45° FOV
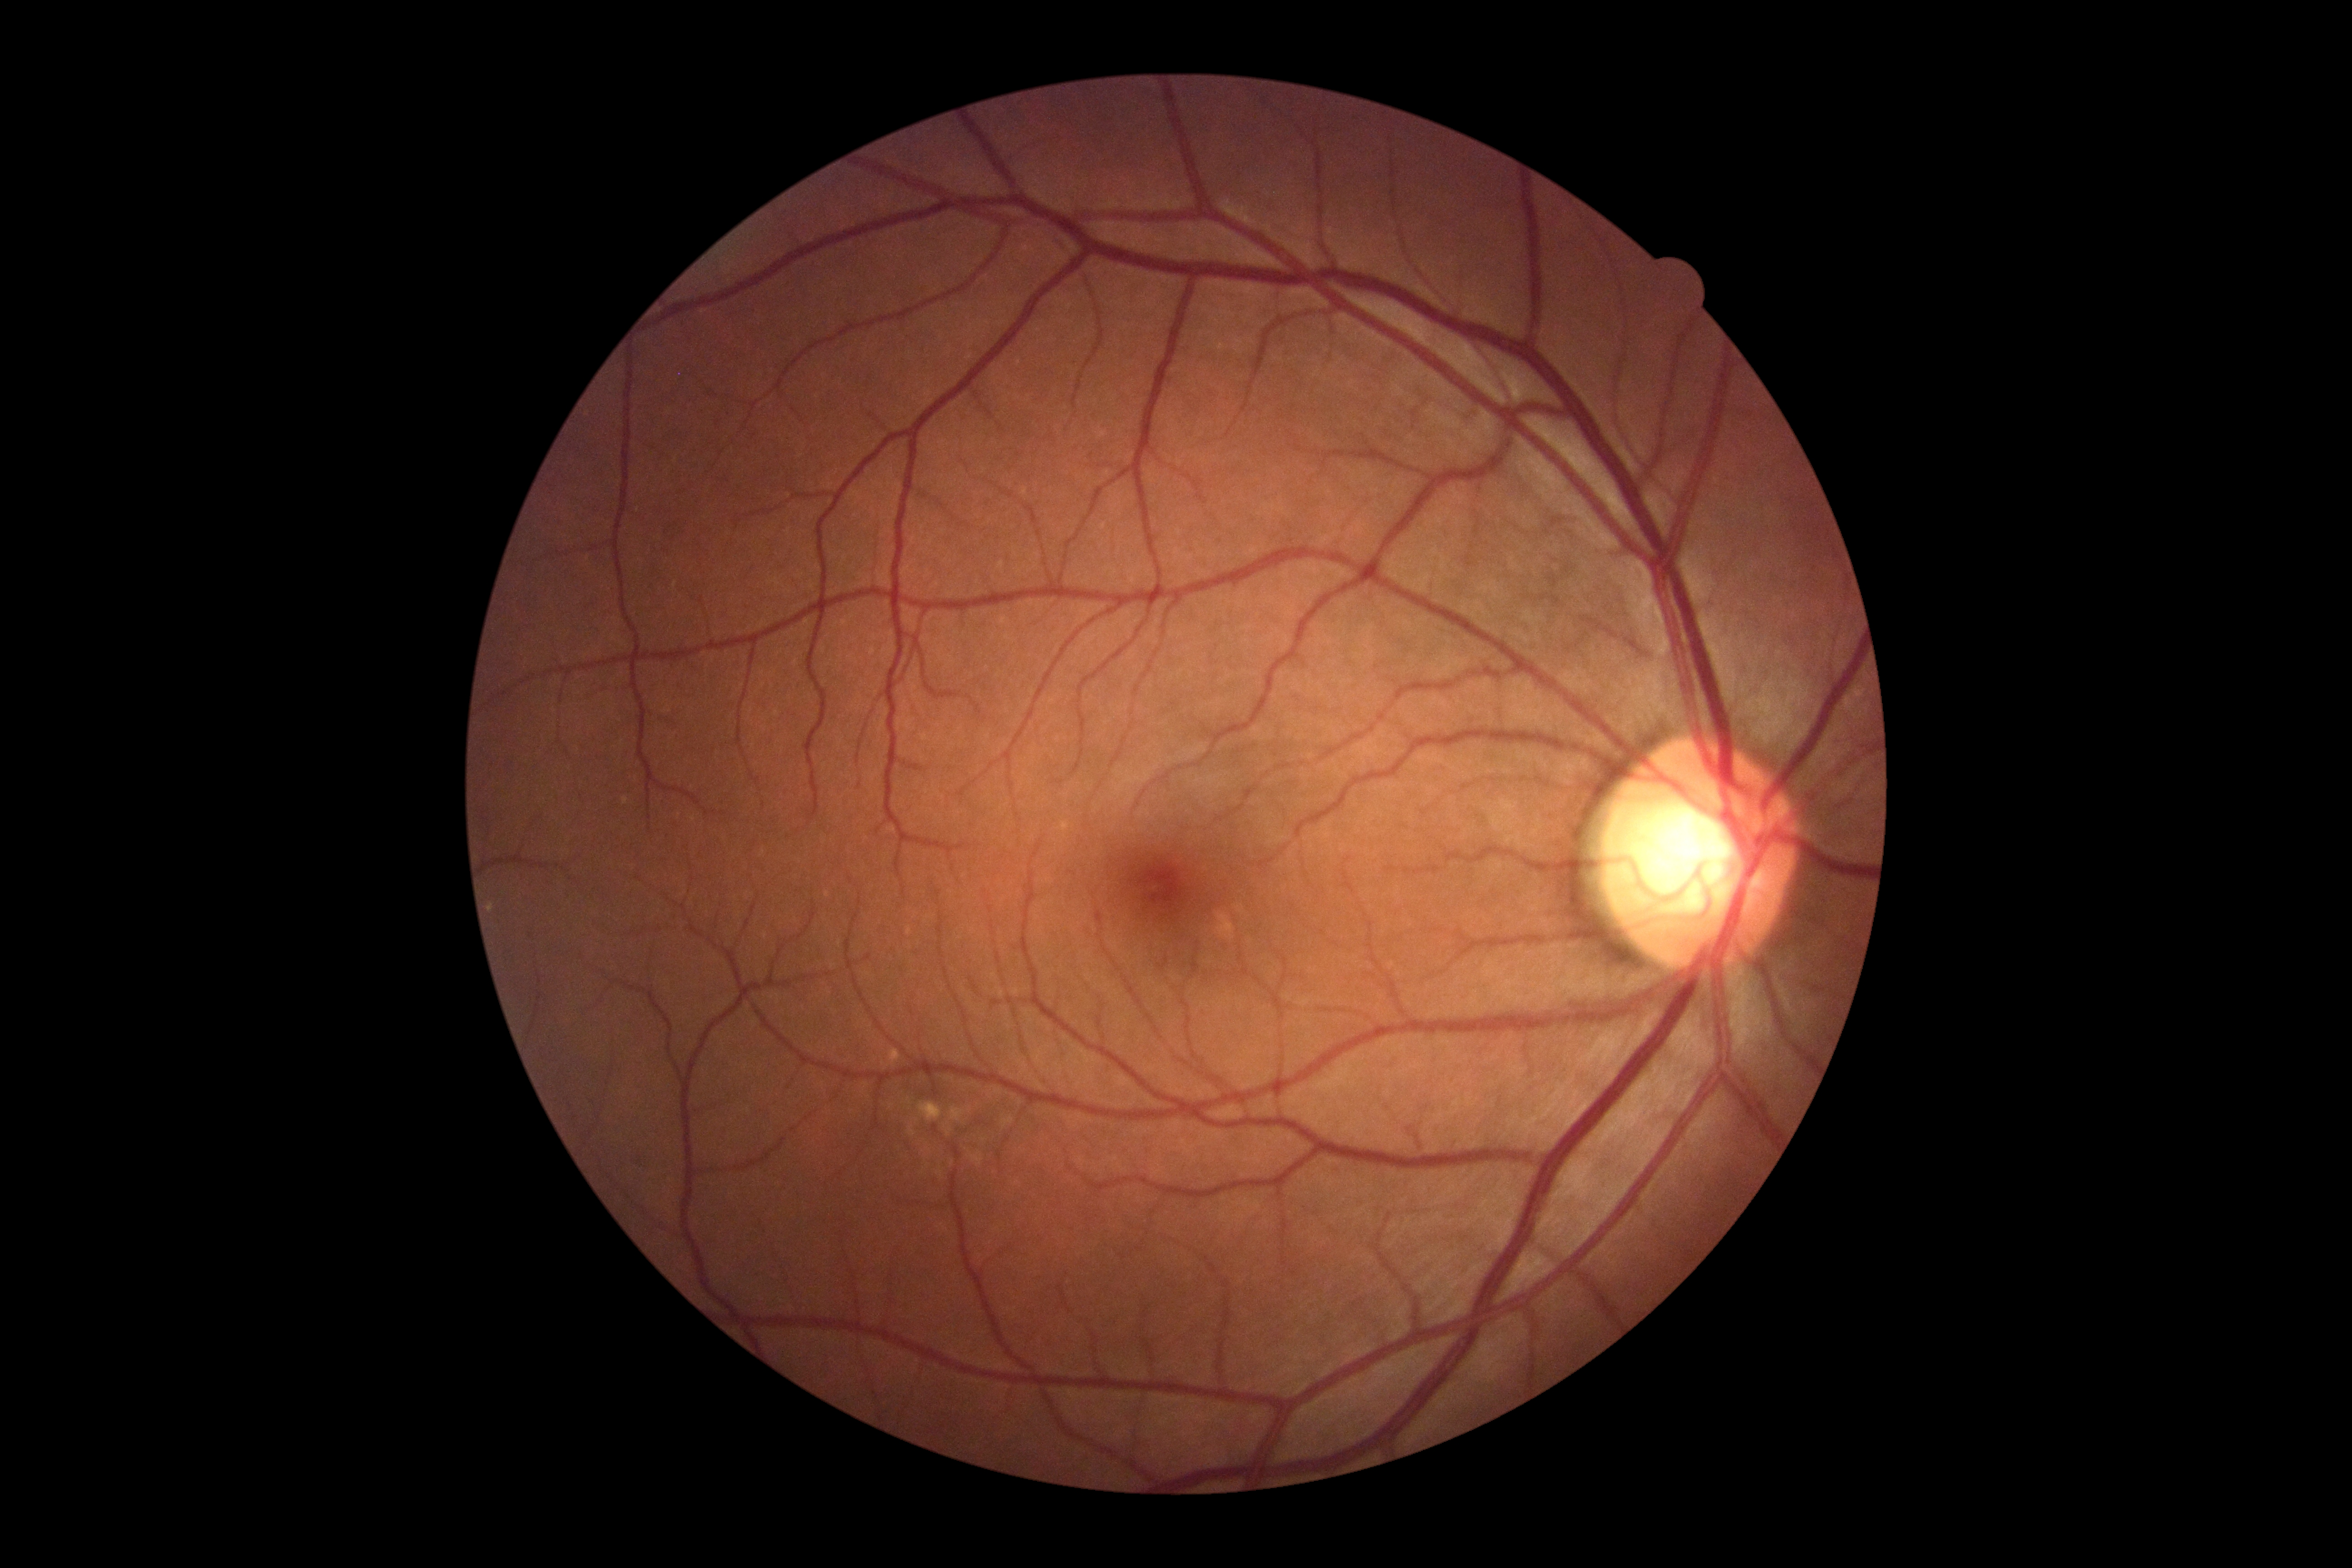 diabetic retinopathy grade@0; DR impression@negative for DR.